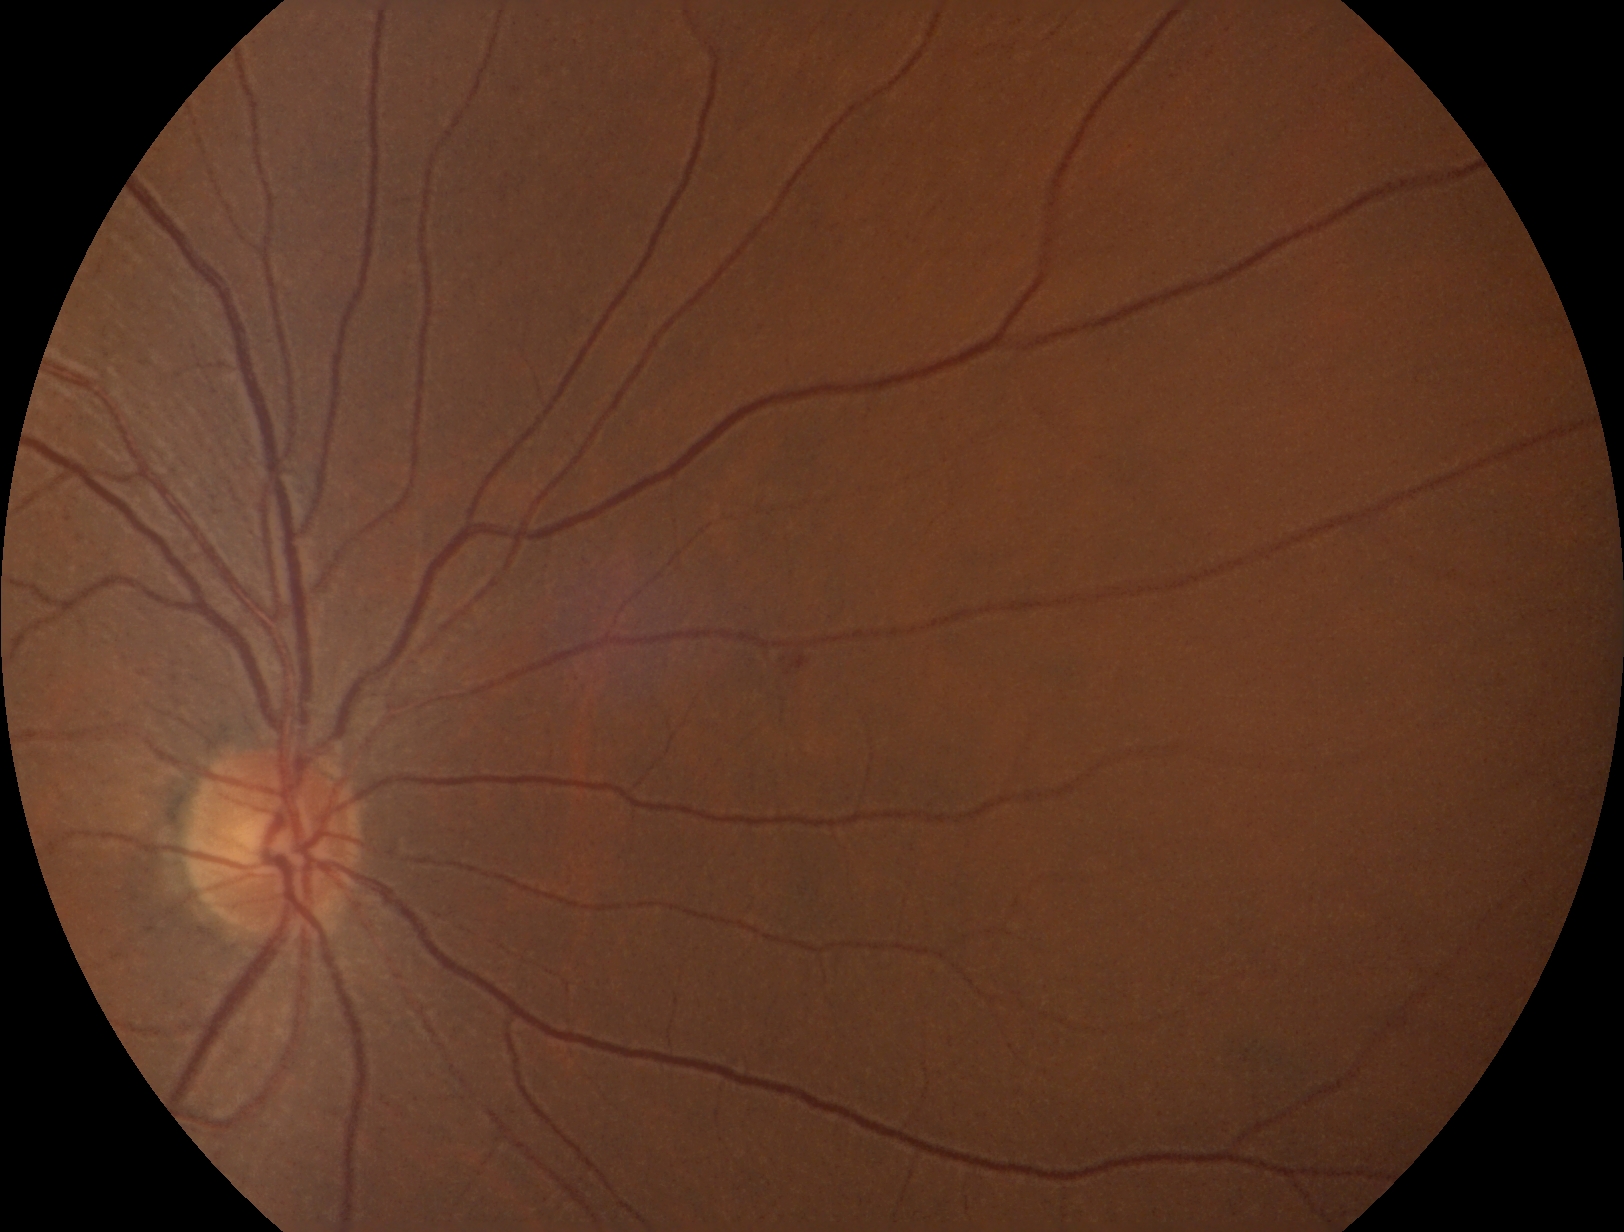
dr_grade: grade 2